Without pupil dilation. Modified Davis classification
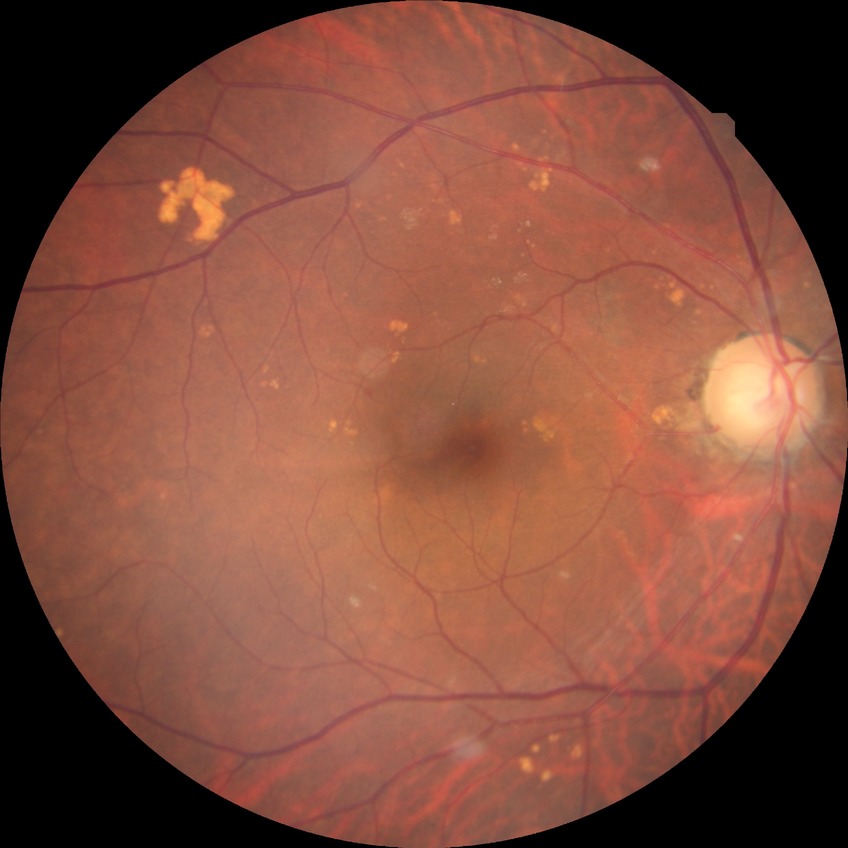

Assessment:
- diabetic retinopathy (DR): NDR (no diabetic retinopathy)